Infant wide-field retinal image · 1440 by 1080 pixels — 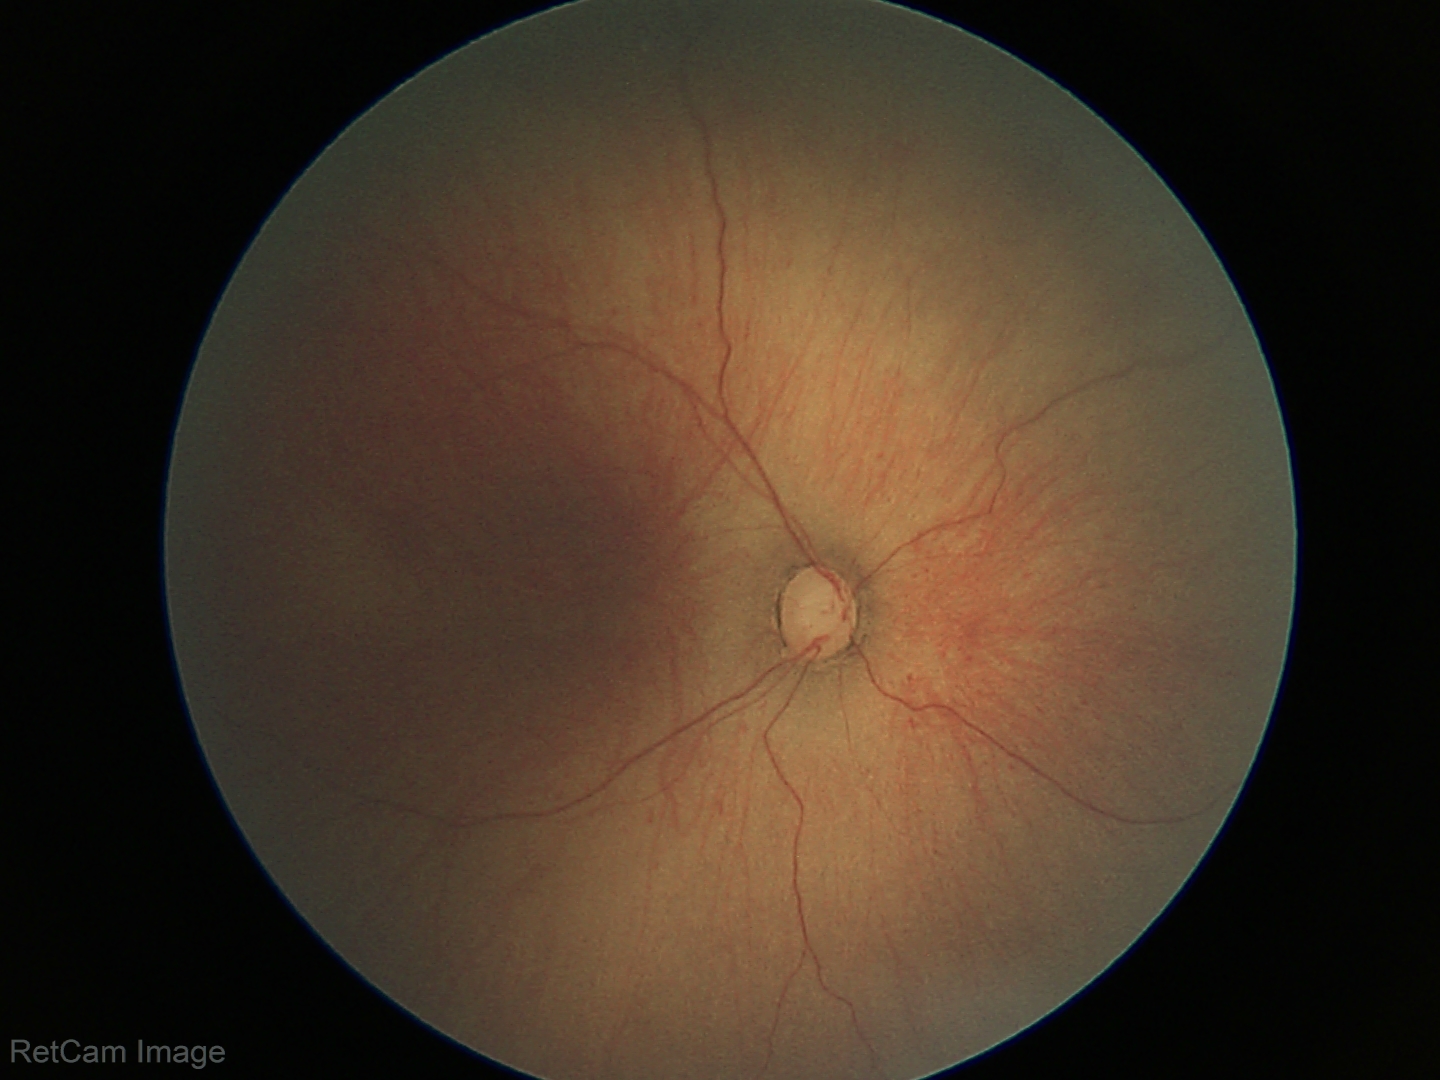
Examination diagnosed as ROP stage 1.